Nonmydriatic fundus photograph; NIDEK AFC-230 fundus camera; posterior pole photograph: 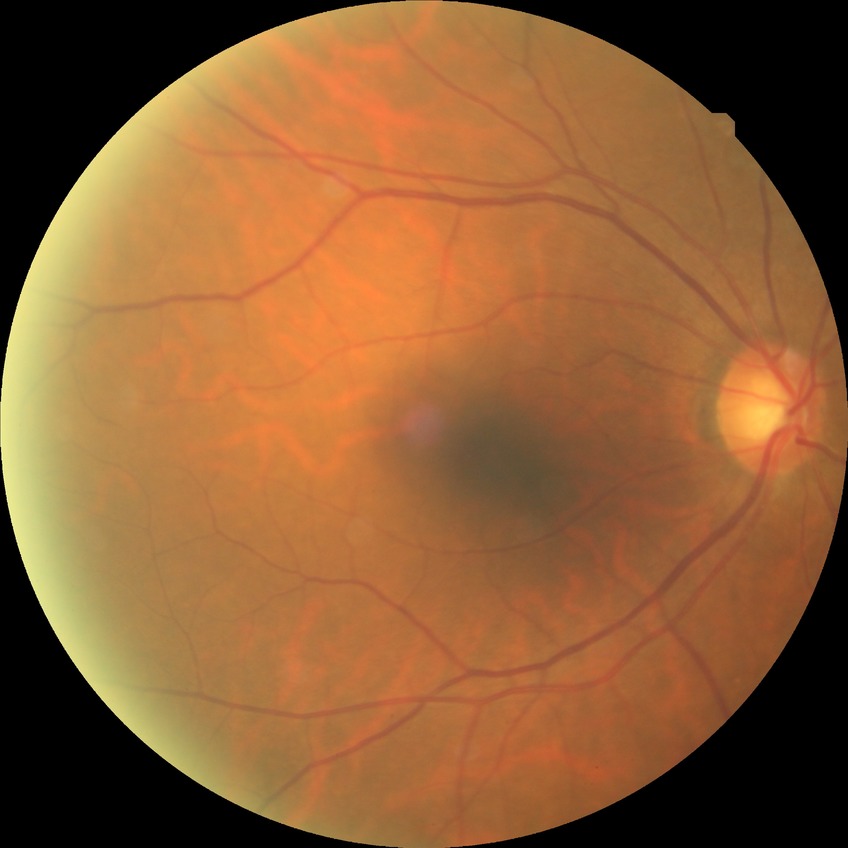
modified Davis grading: no diabetic retinopathy.